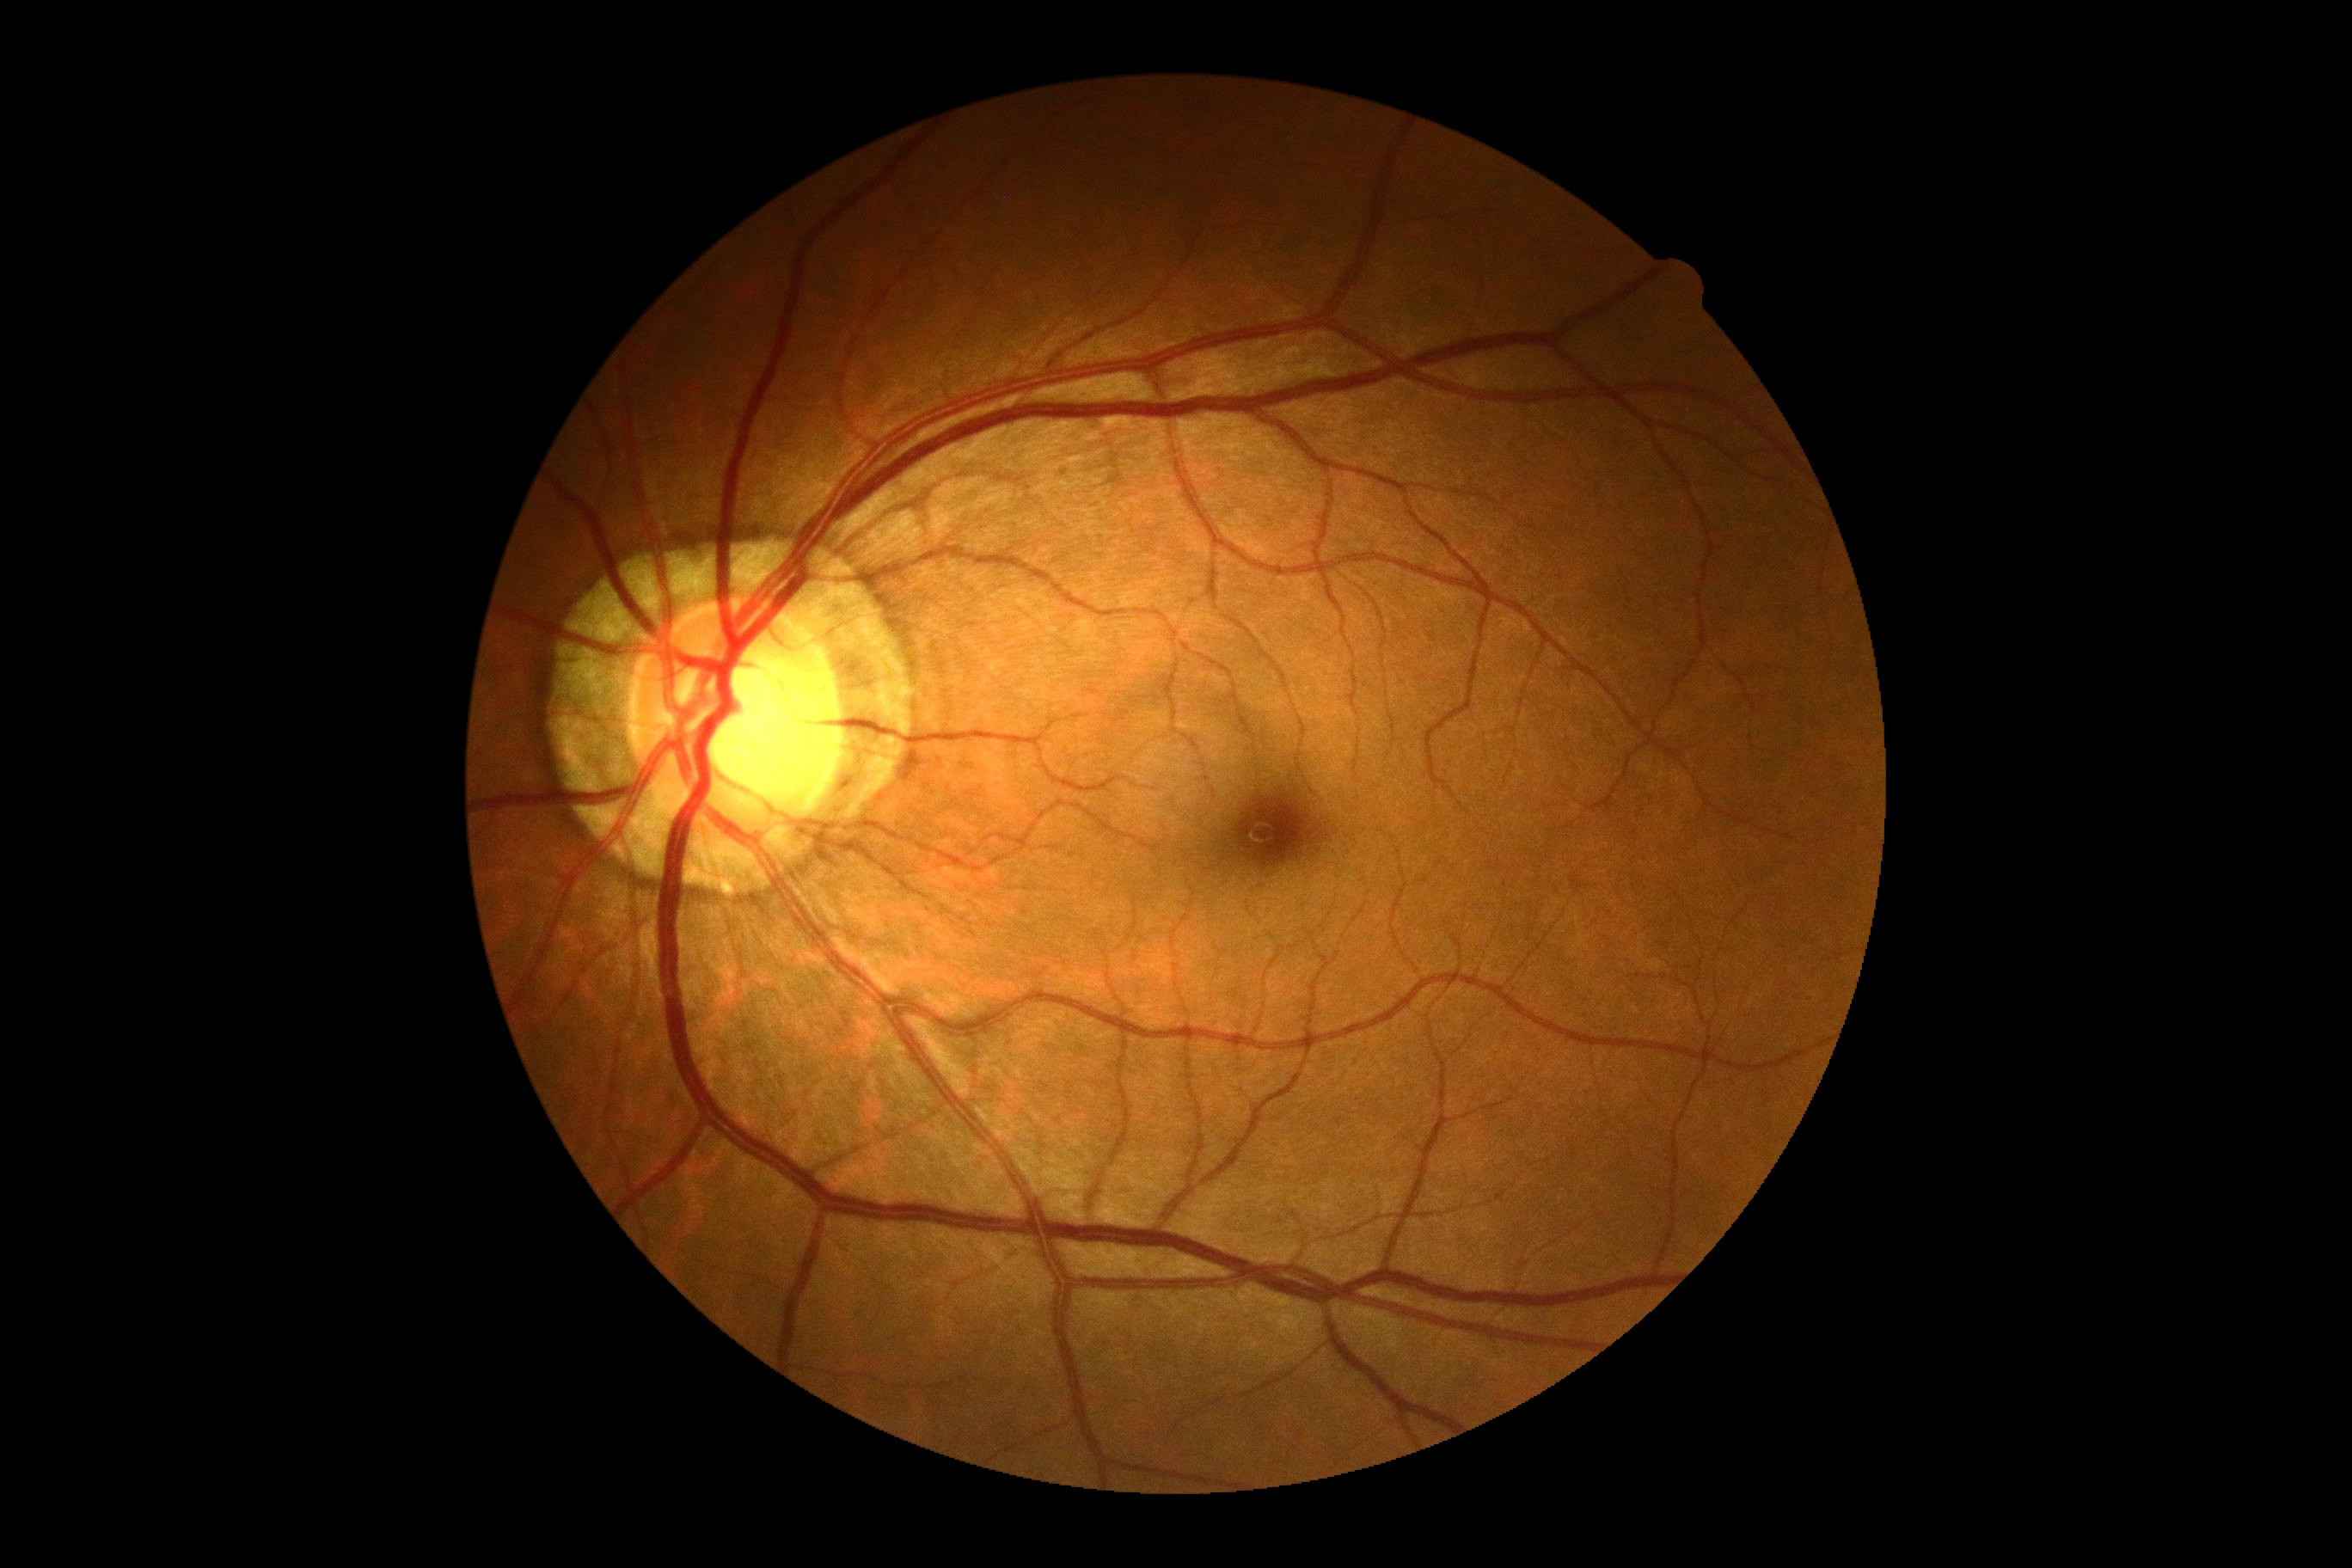
DR severity is grade 0 — no visible signs of diabetic retinopathy. No signs of diabetic retinopathy.